50° FOV:
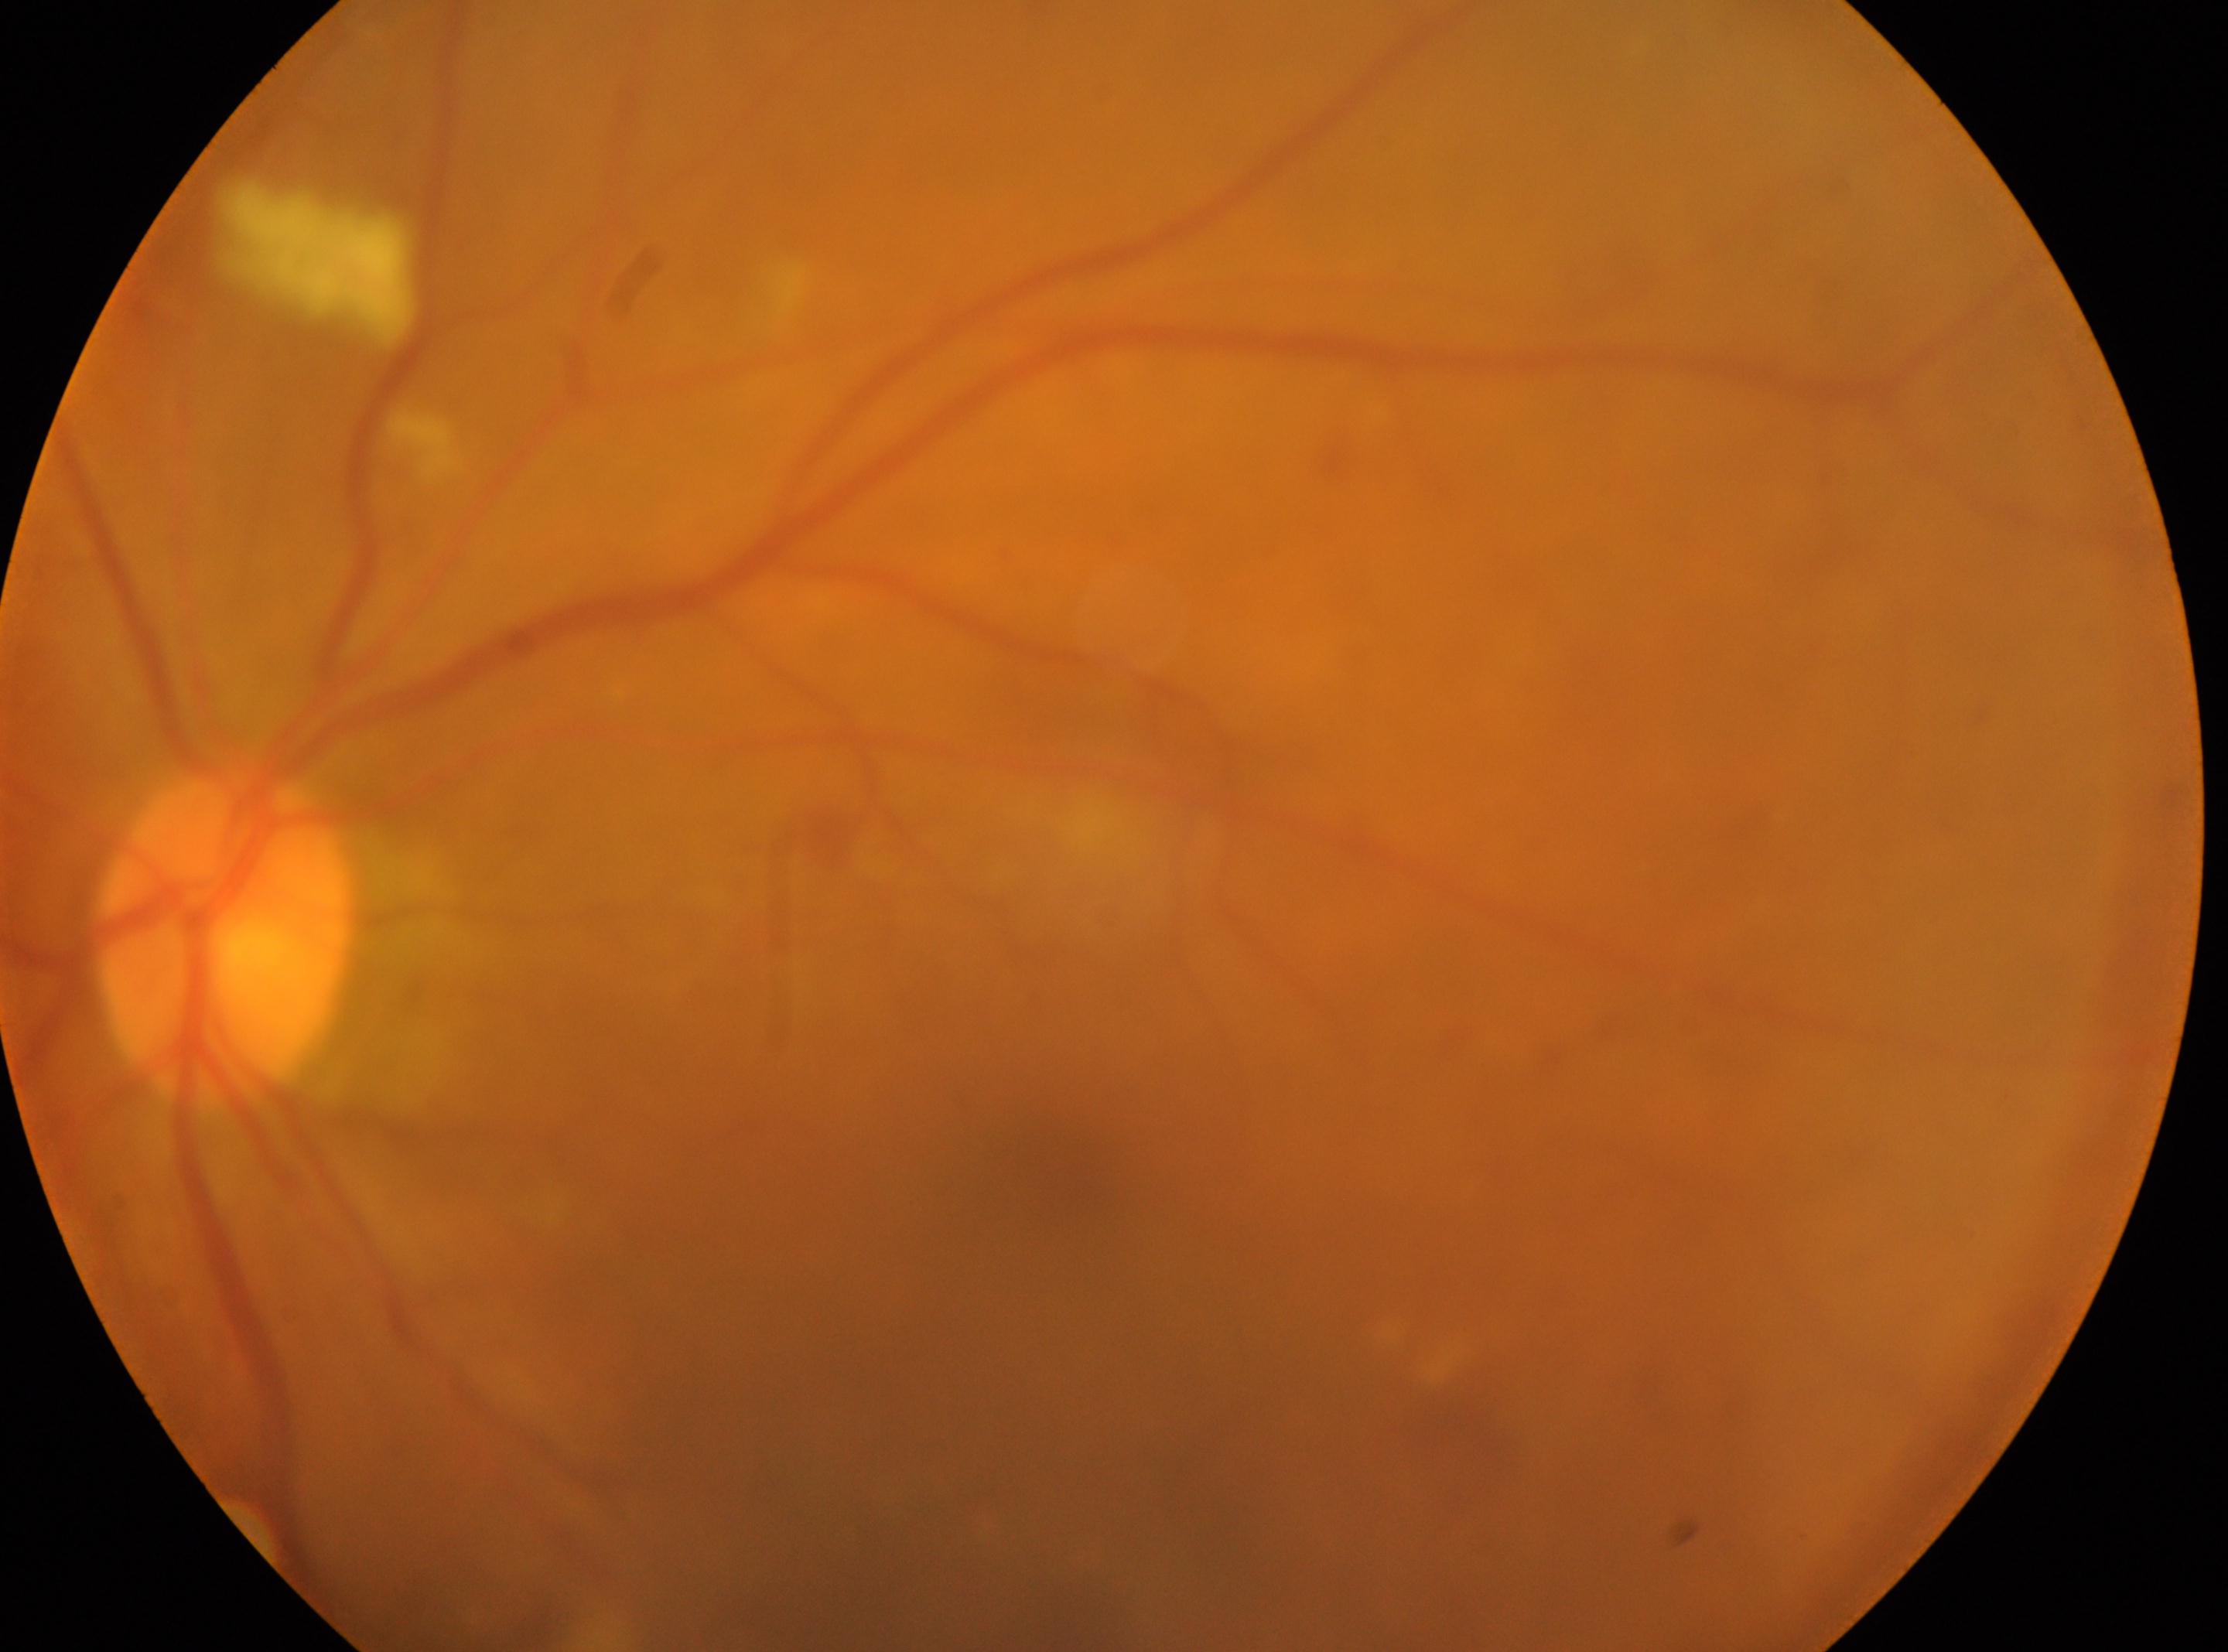
Annotations:
* macula center — 1055, 1179
* DR — 2/4
* laterality — oculus sinister
* ONH — 227, 939